Color fundus photograph; 1932 x 1916 pixels
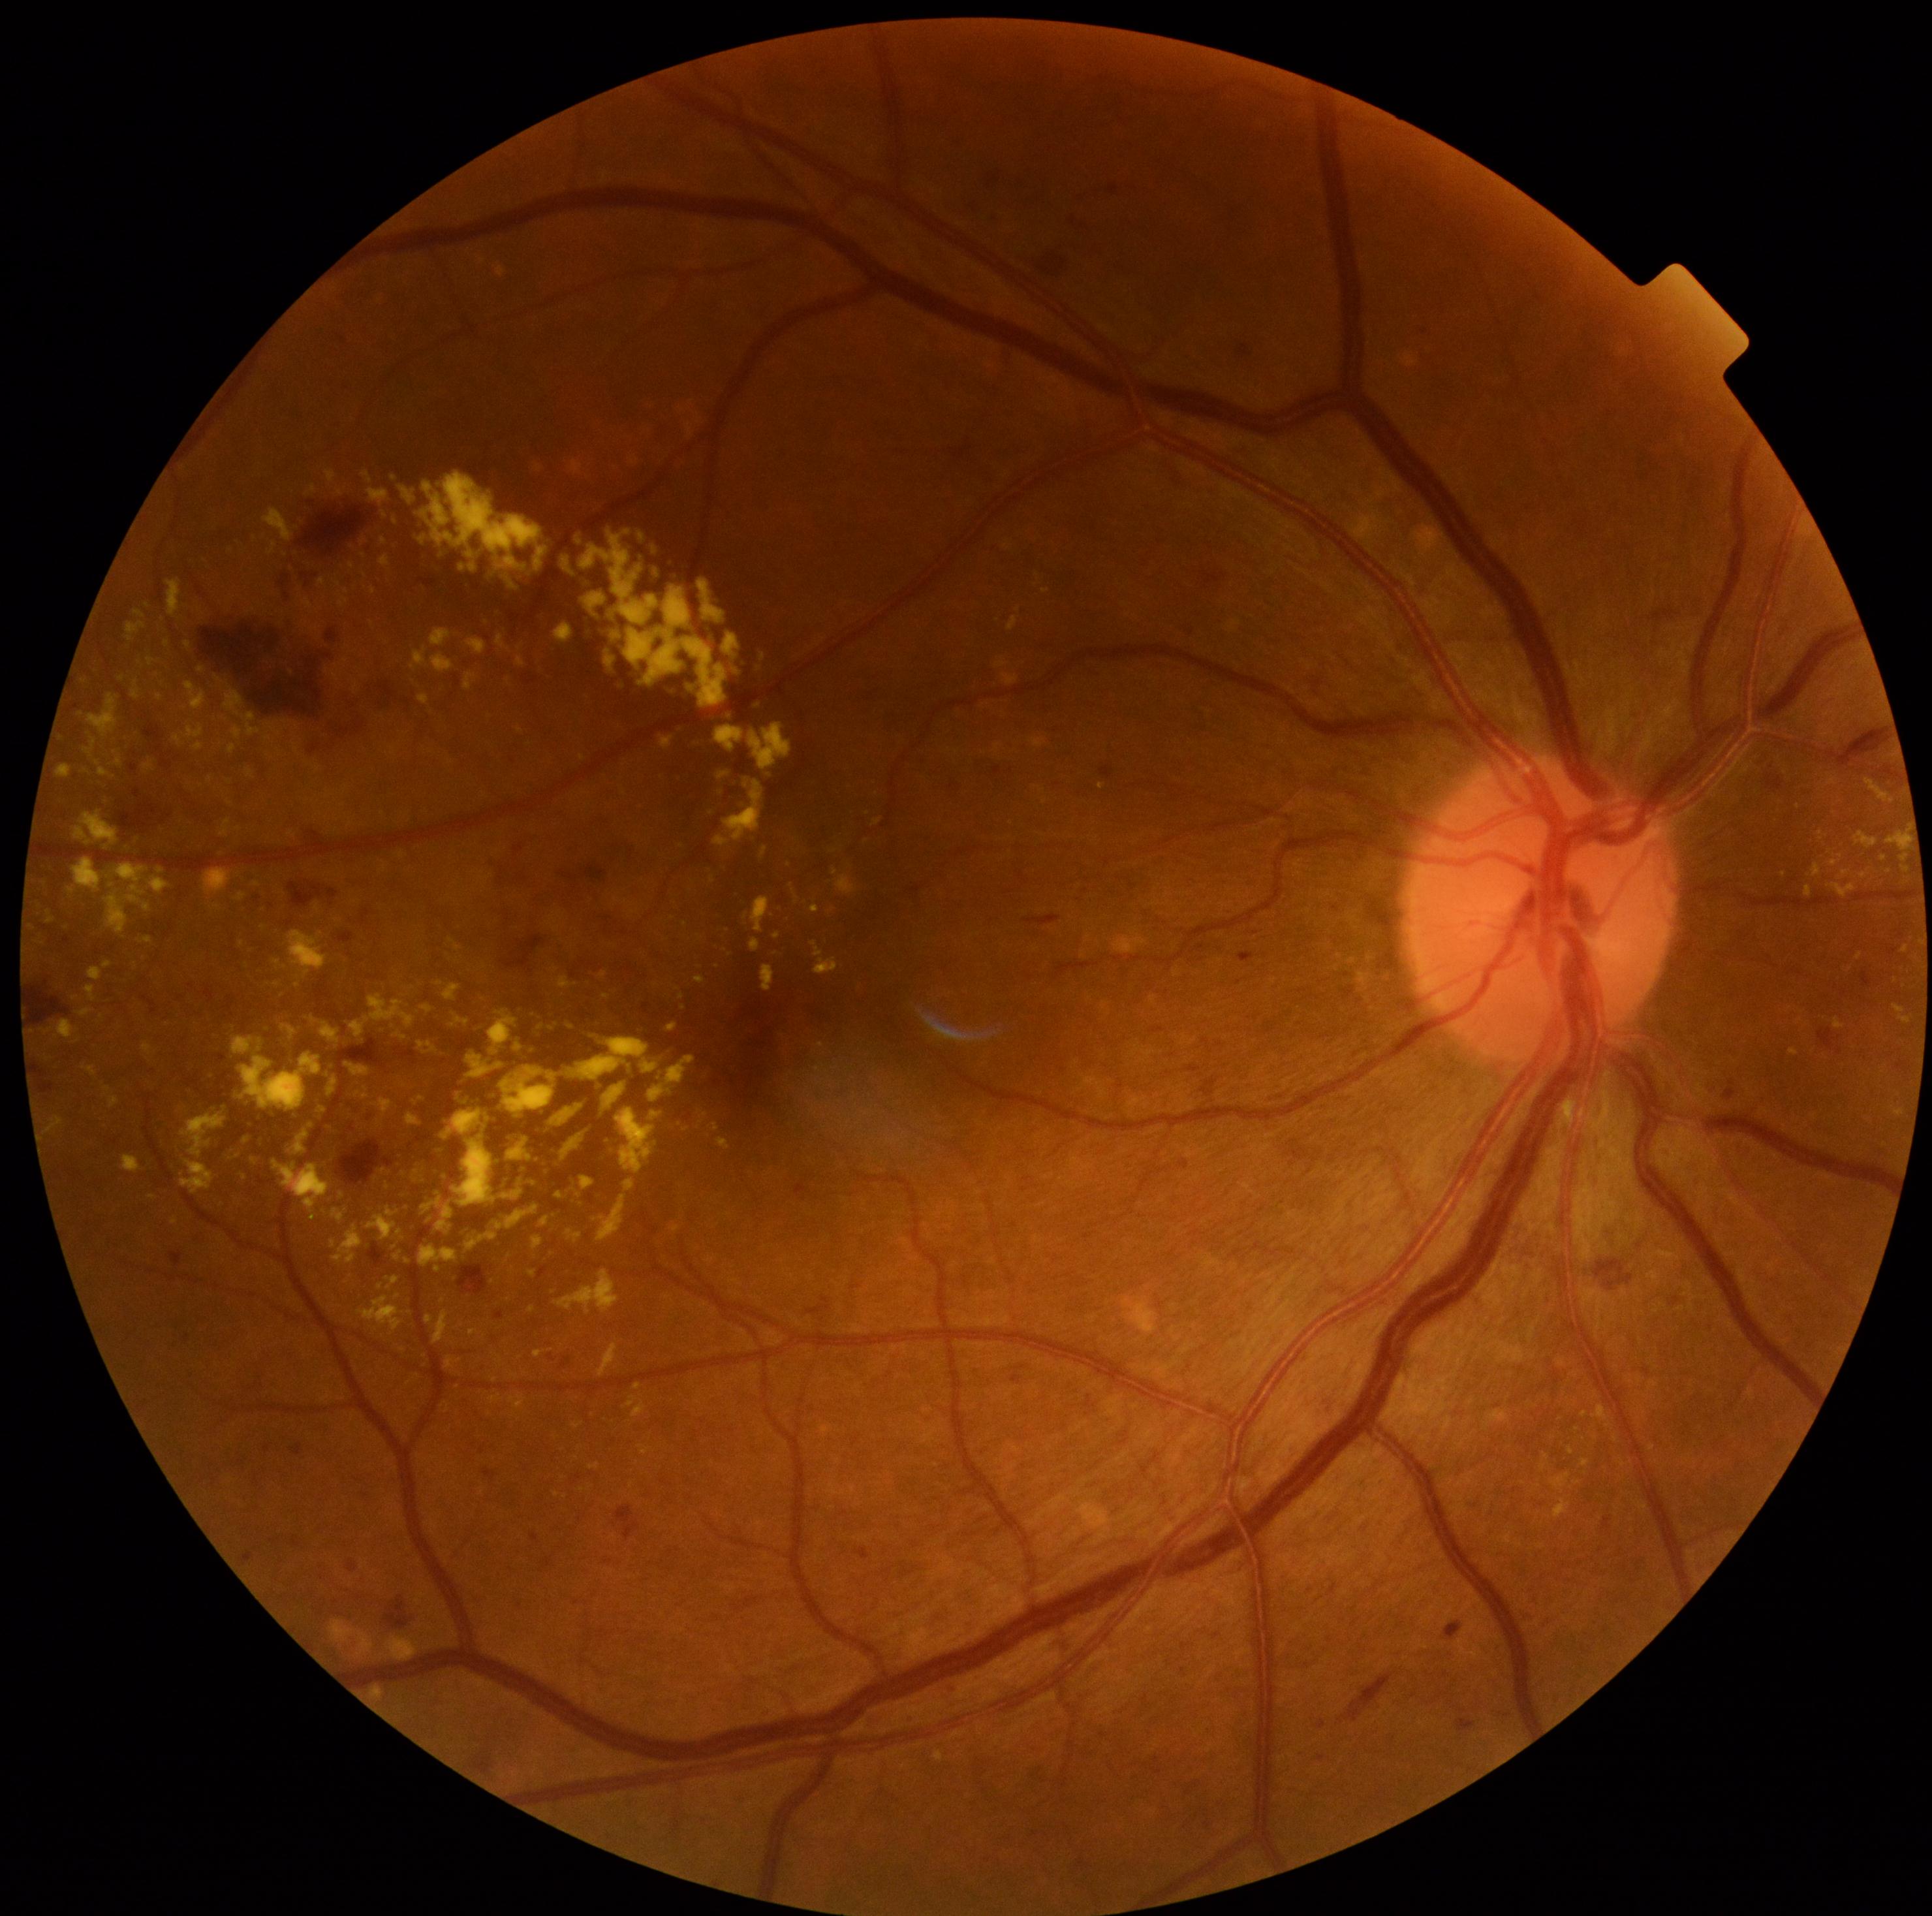
DR is moderate non-proliferative diabetic retinopathy (grade 2)
Representative lesions:
• EXs (continued): BBox(511, 1396, 525, 1409) | BBox(625, 586, 729, 708) | BBox(554, 624, 574, 642) | BBox(750, 1366, 756, 1374) | BBox(738, 1329, 747, 1336) | BBox(332, 1208, 348, 1225) | BBox(490, 1394, 503, 1404) | BBox(335, 490, 345, 497) | BBox(465, 1231, 498, 1251) | BBox(668, 1022, 677, 1033) | BBox(181, 1159, 215, 1195) | BBox(268, 542, 277, 558) | BBox(139, 937, 152, 943)
• Smaller EXs around 832/911 | 338/583 | 122/679 | 253/612 | 770/775 | 678/989 | 325/1212